Color fundus photograph: 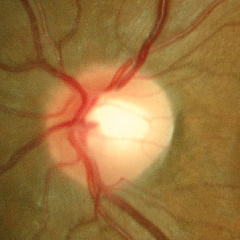 Impression: no glaucomatous optic neuropathy.